Wide-field fundus photograph from neonatal ROP screening:
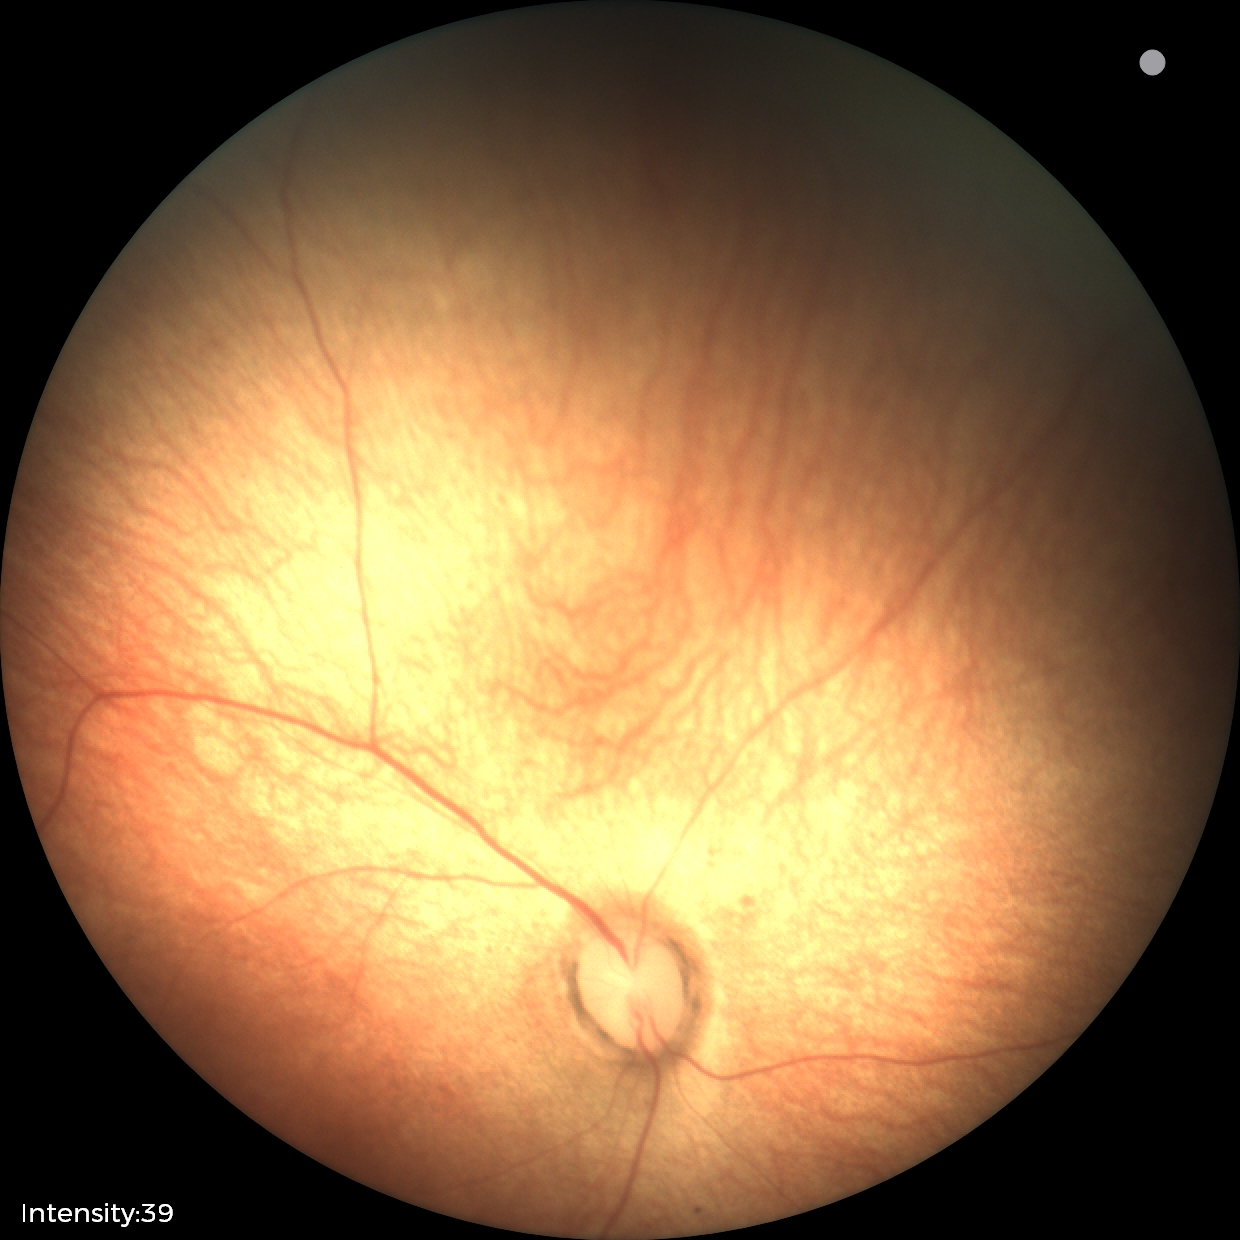
Examination with physiological retinal findings.